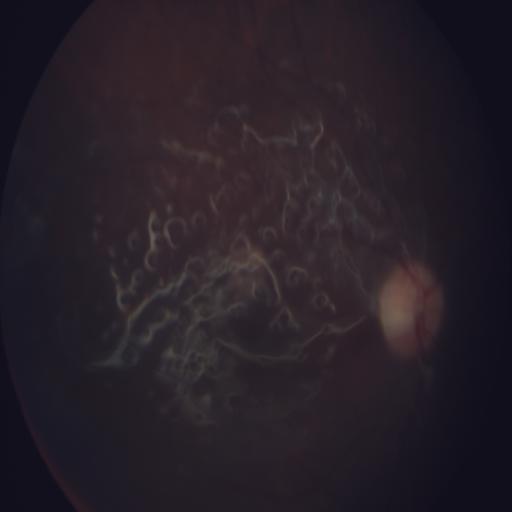

Pathology: silicone oil-filled eye.